Color fundus photograph; camera: NIDEK AFC-230; 848 x 848 pixels; nonmydriatic fundus photograph: 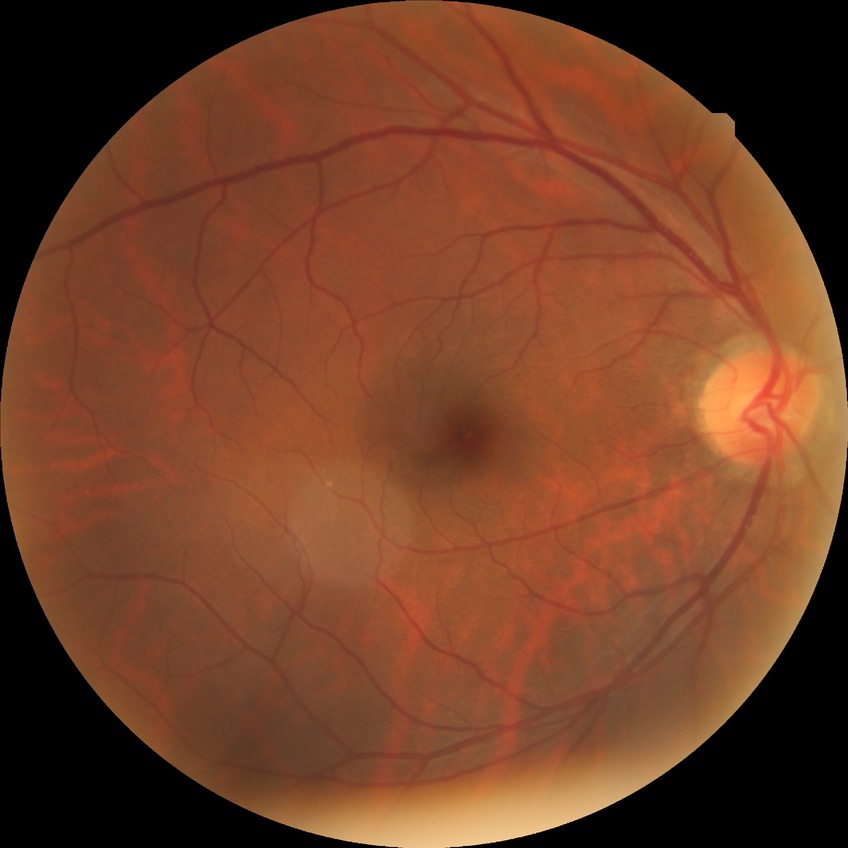
diabetic retinopathy (DR)@simple diabetic retinopathy (SDR).